45° FOV, posterior pole photograph, NIDEK AFC-230, 848x848, graded on the modified Davis scale
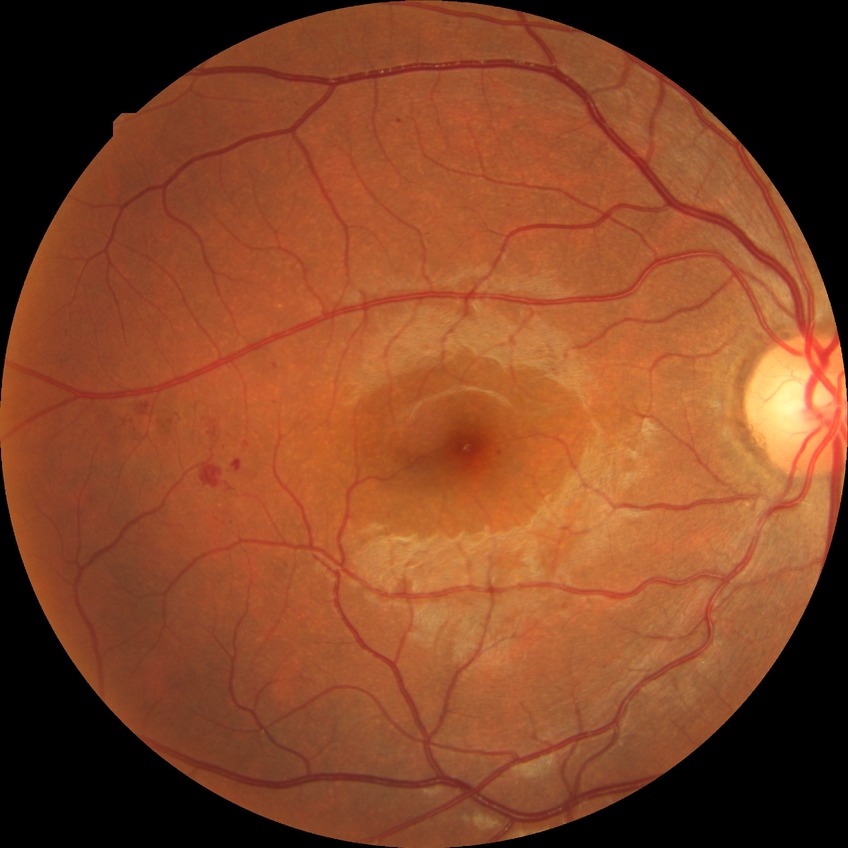

Findings:
- DR class: non-proliferative diabetic retinopathy
- retinopathy stage: simple diabetic retinopathy